45° field of view, color fundus photograph
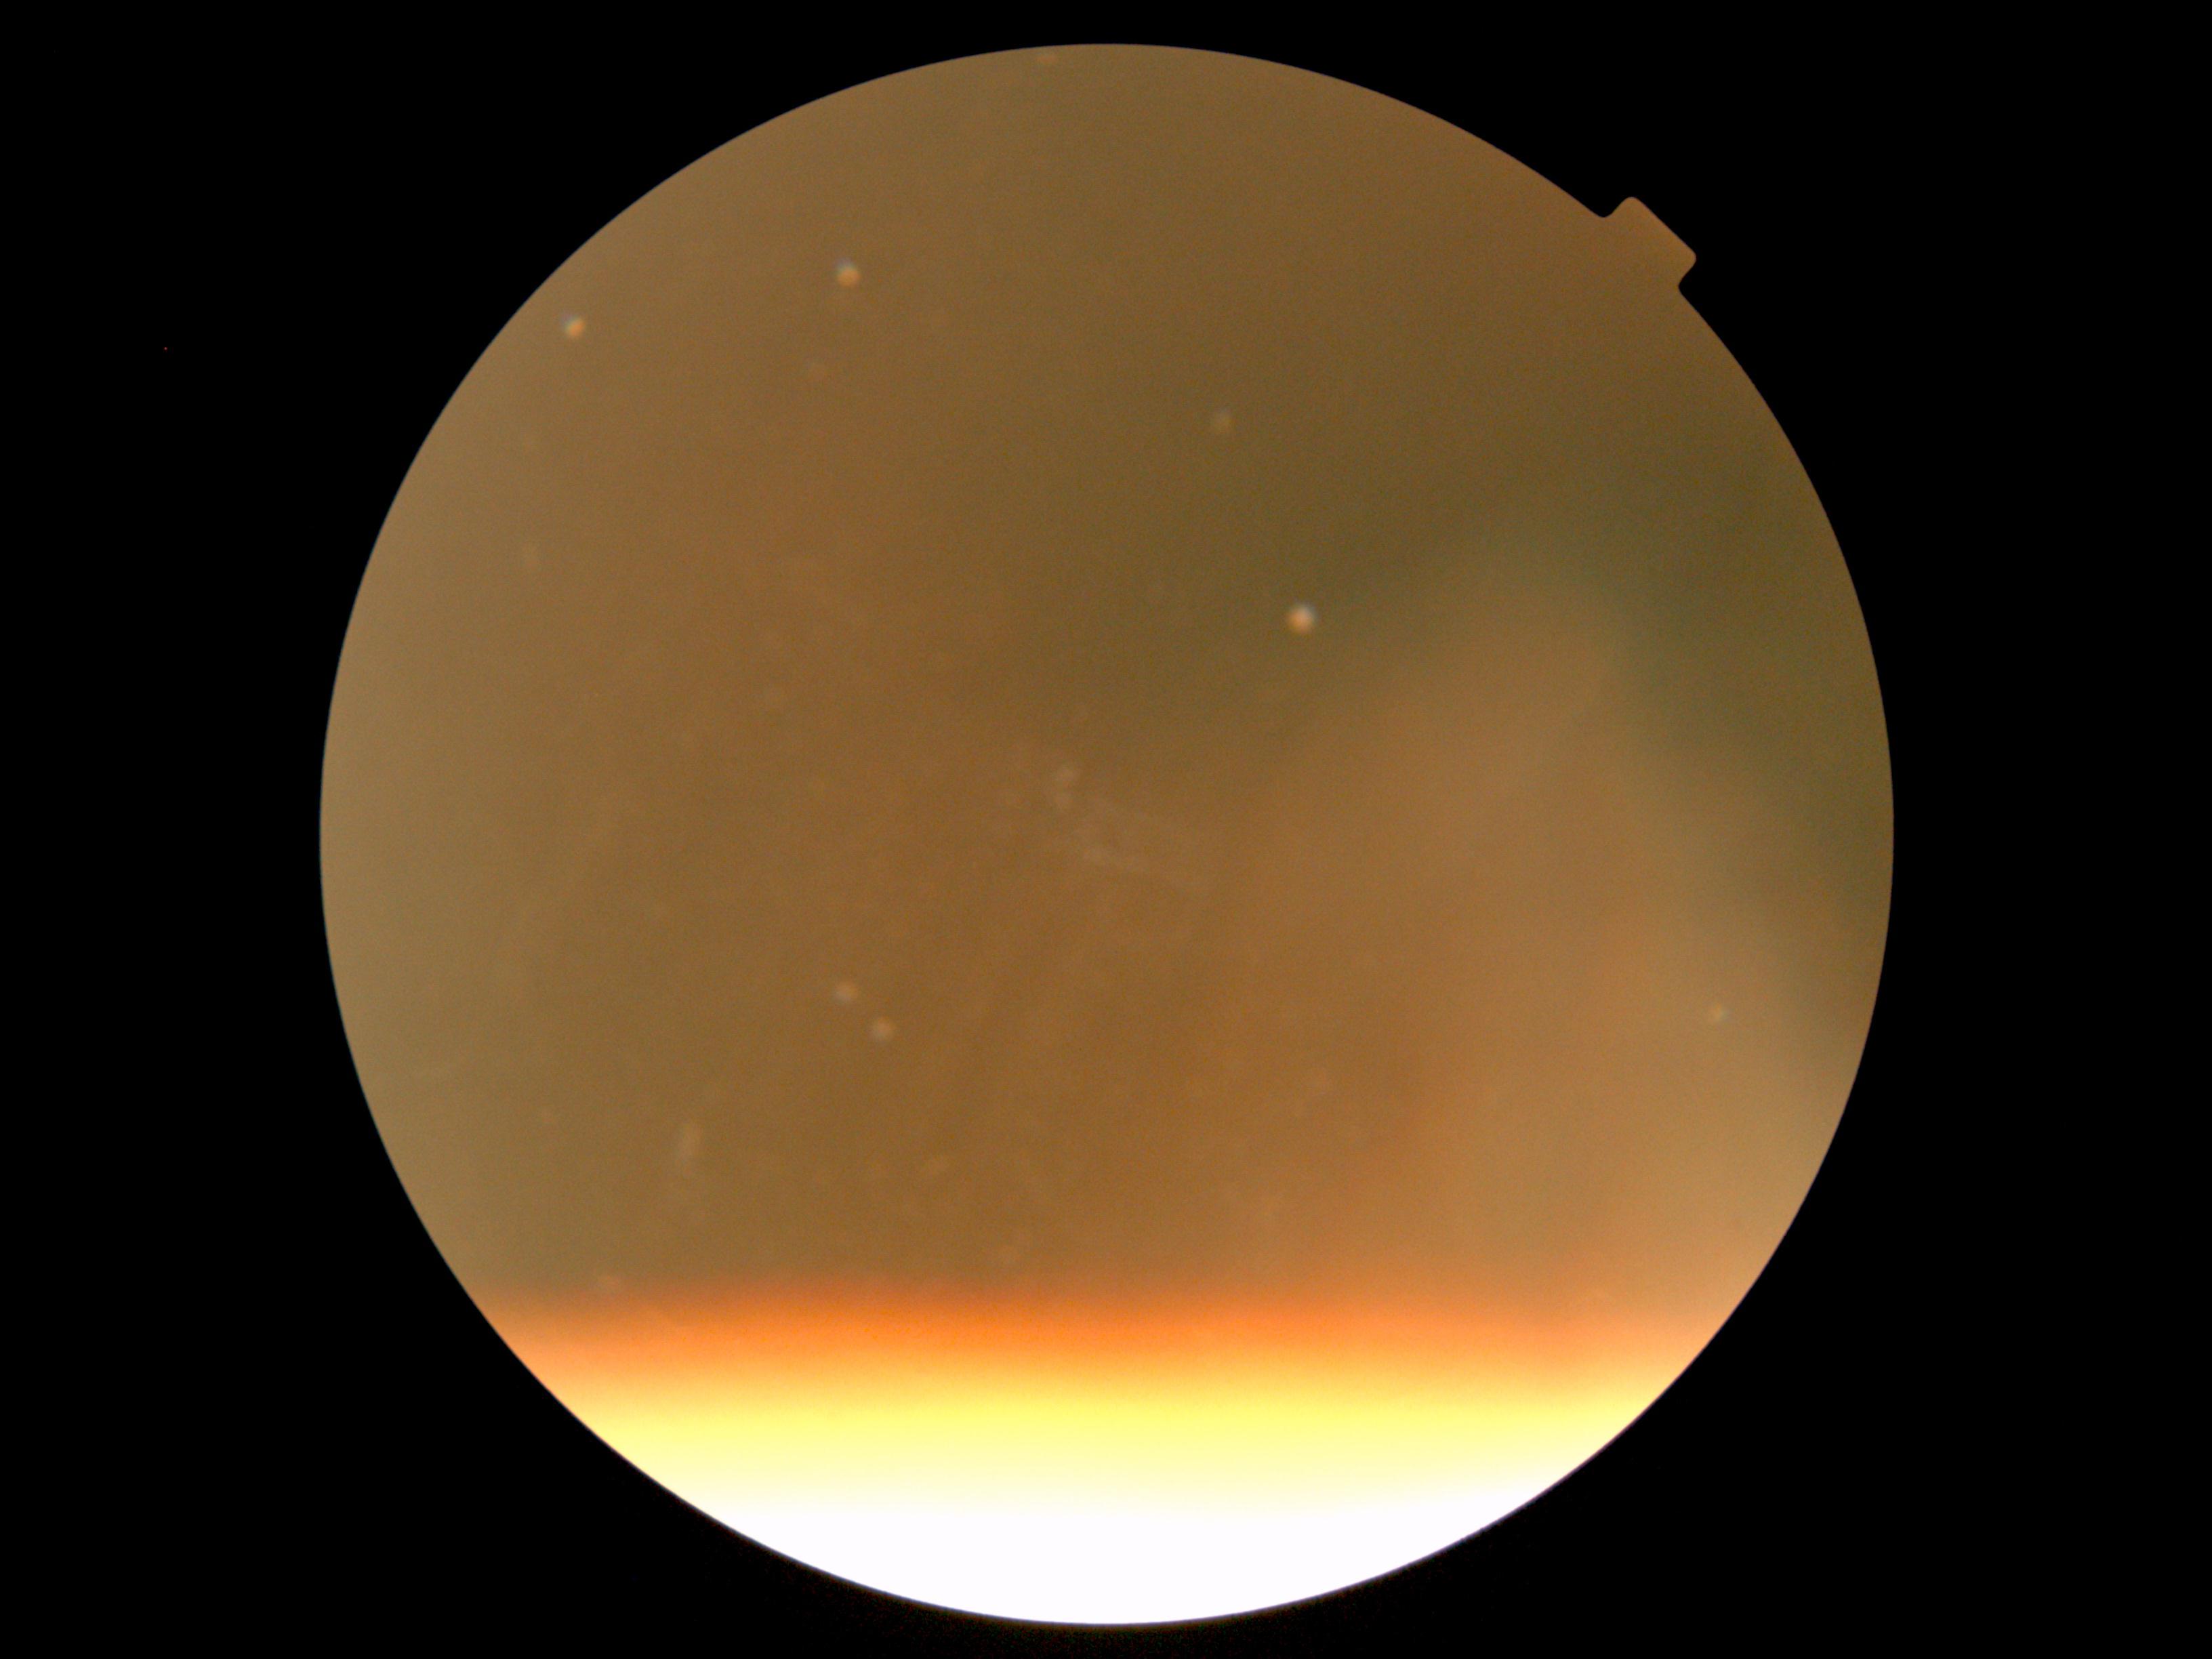

* diabetic retinopathy (DR) — ungradable due to poor image quality
* image quality — below grading threshold